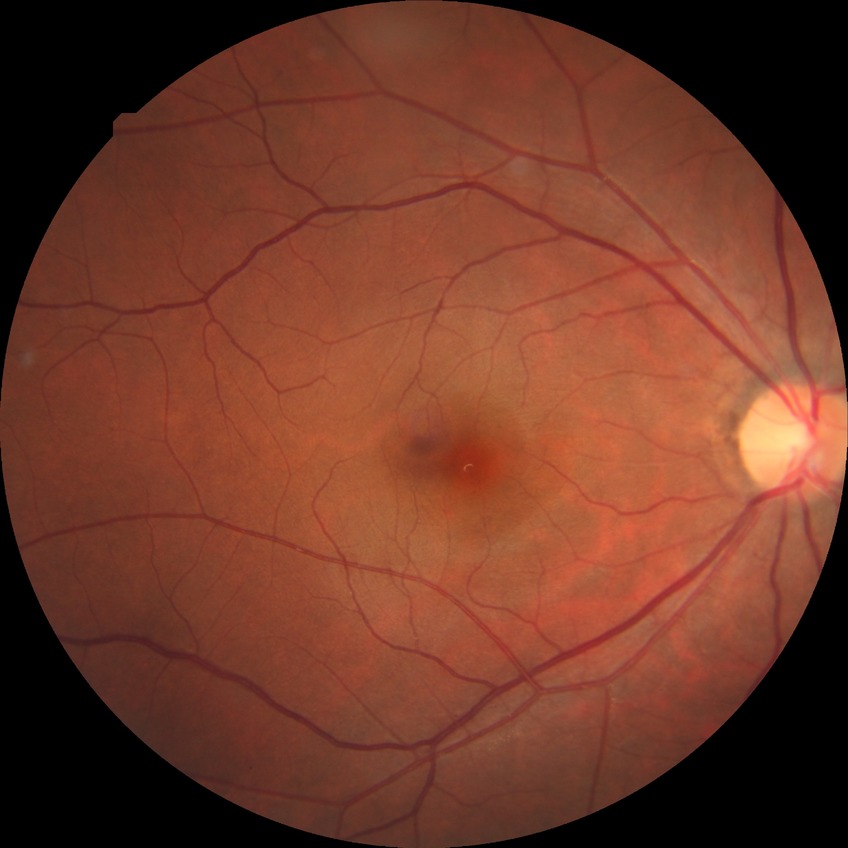

Diabetic retinopathy grade is no diabetic retinopathy.